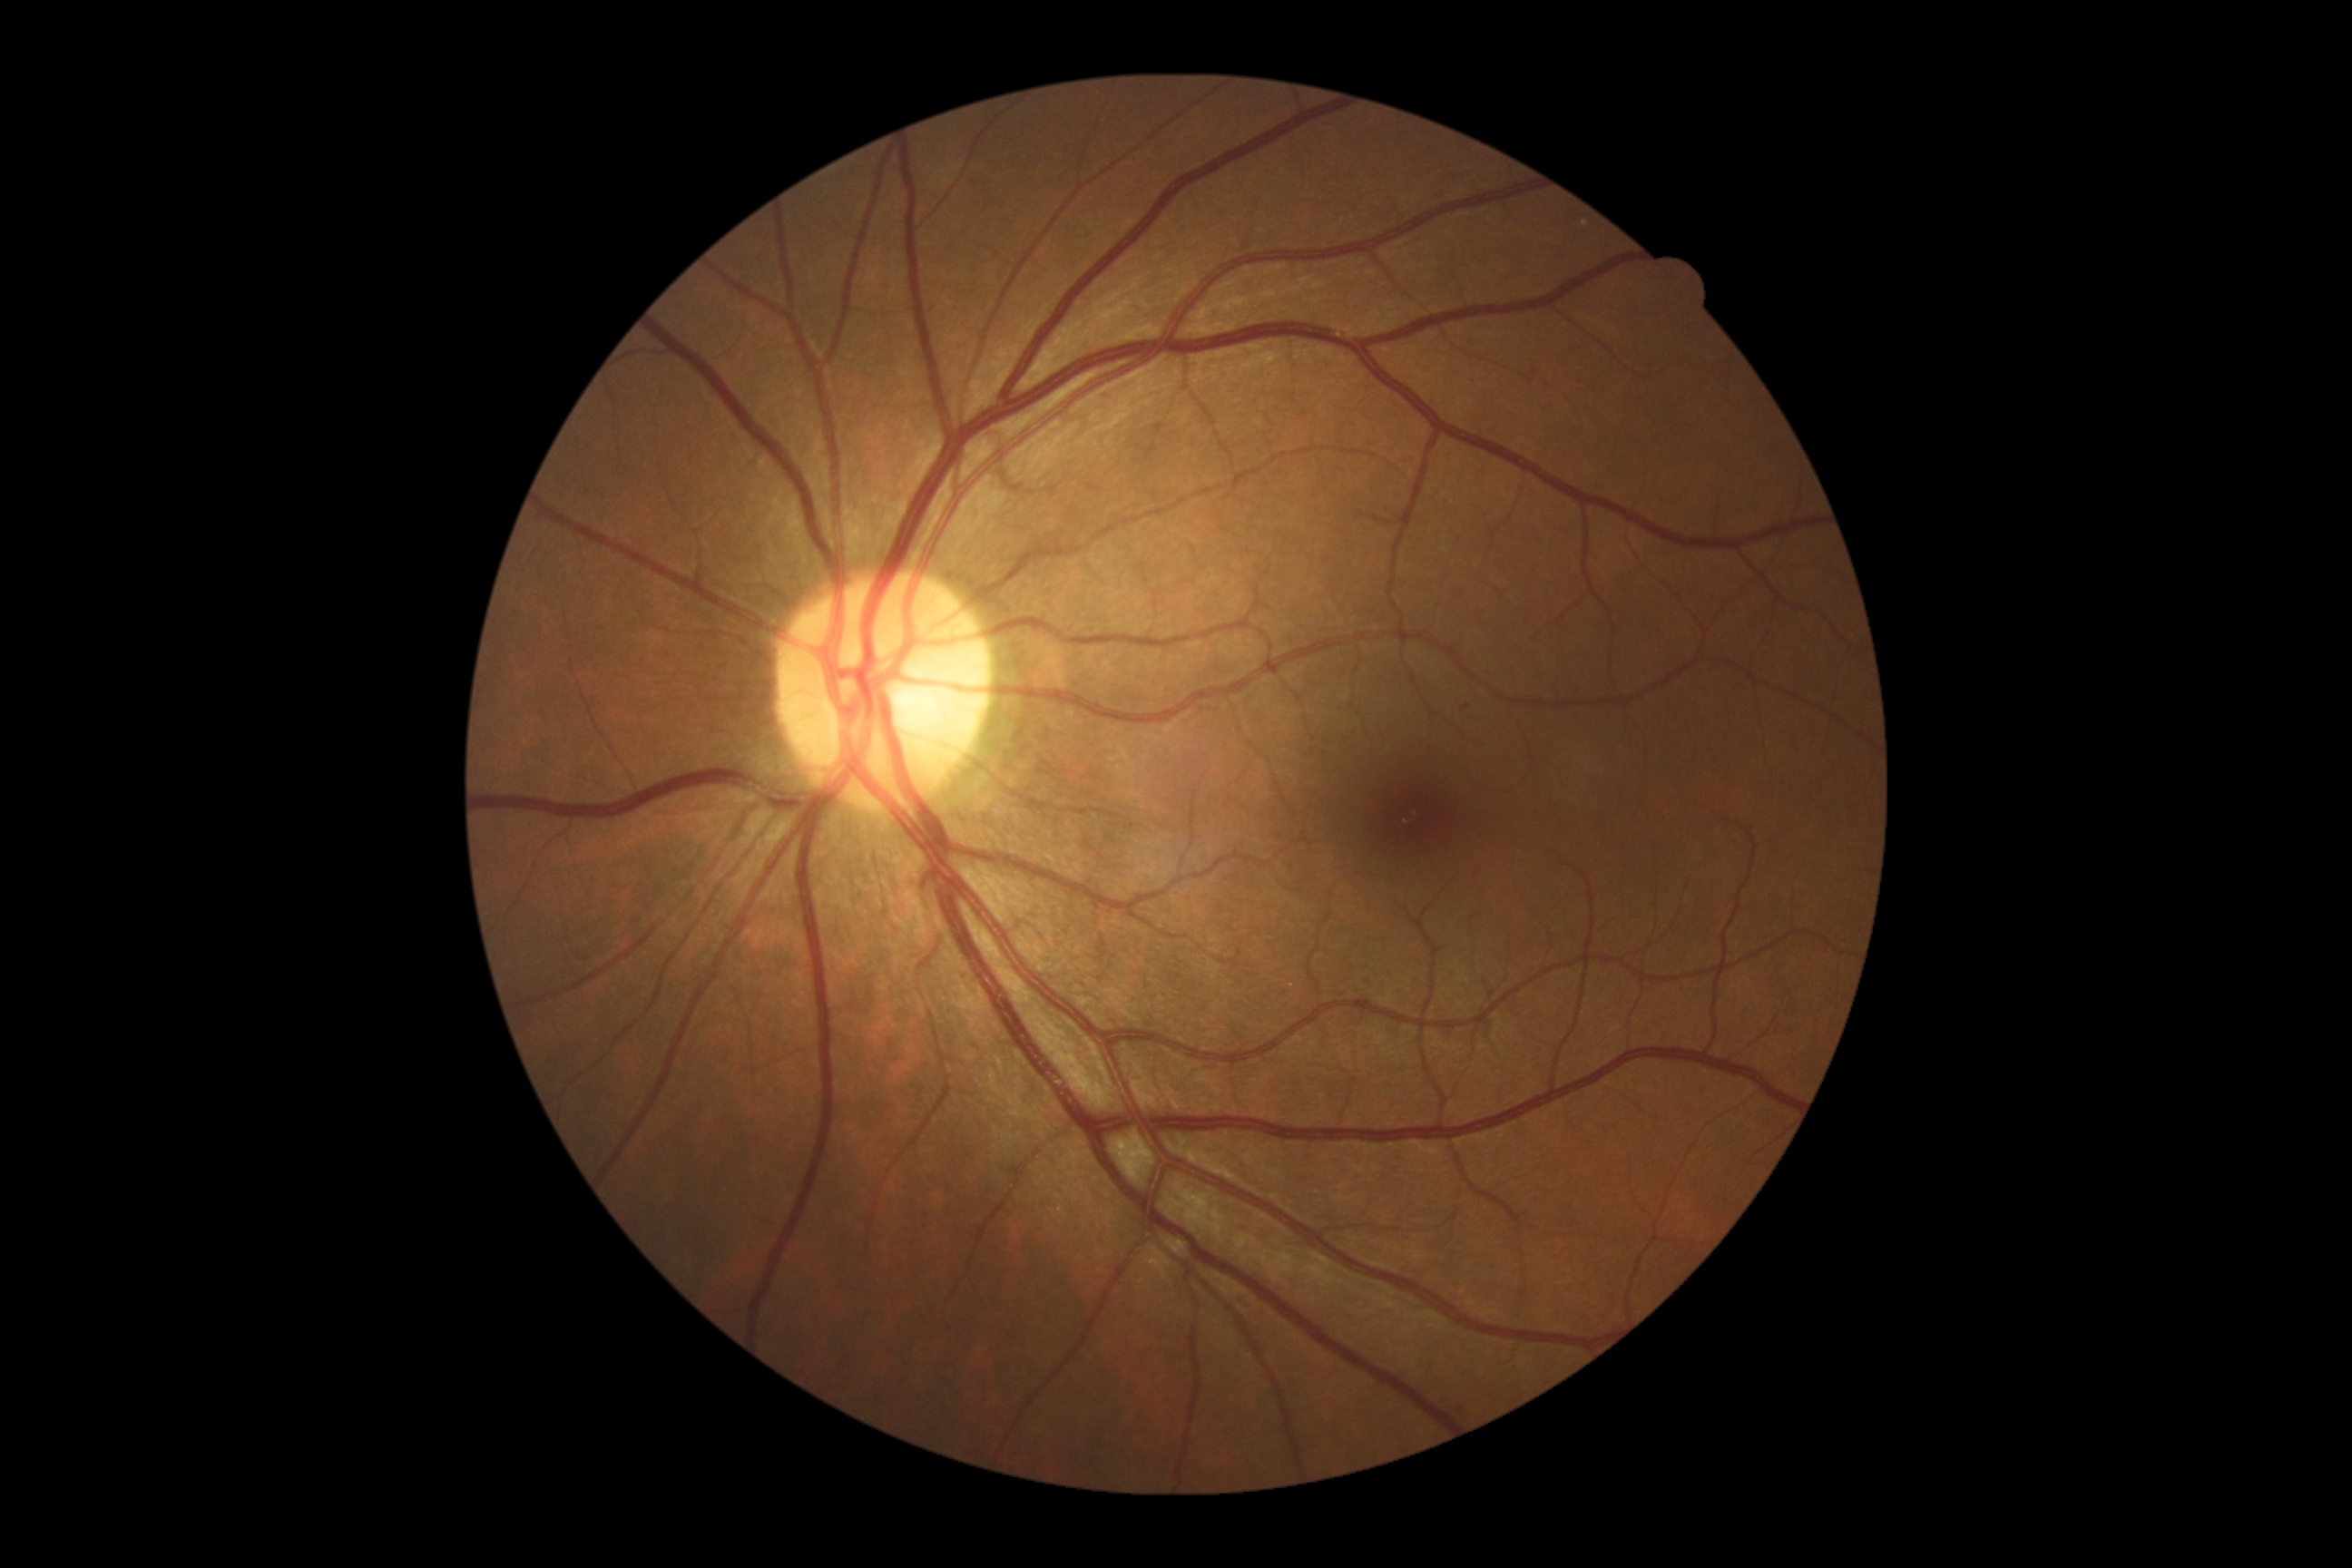 Findings:
* DR stage — 1